100° field of view (Phoenix ICON) · 1240x1240 · wide-field fundus photograph of an infant
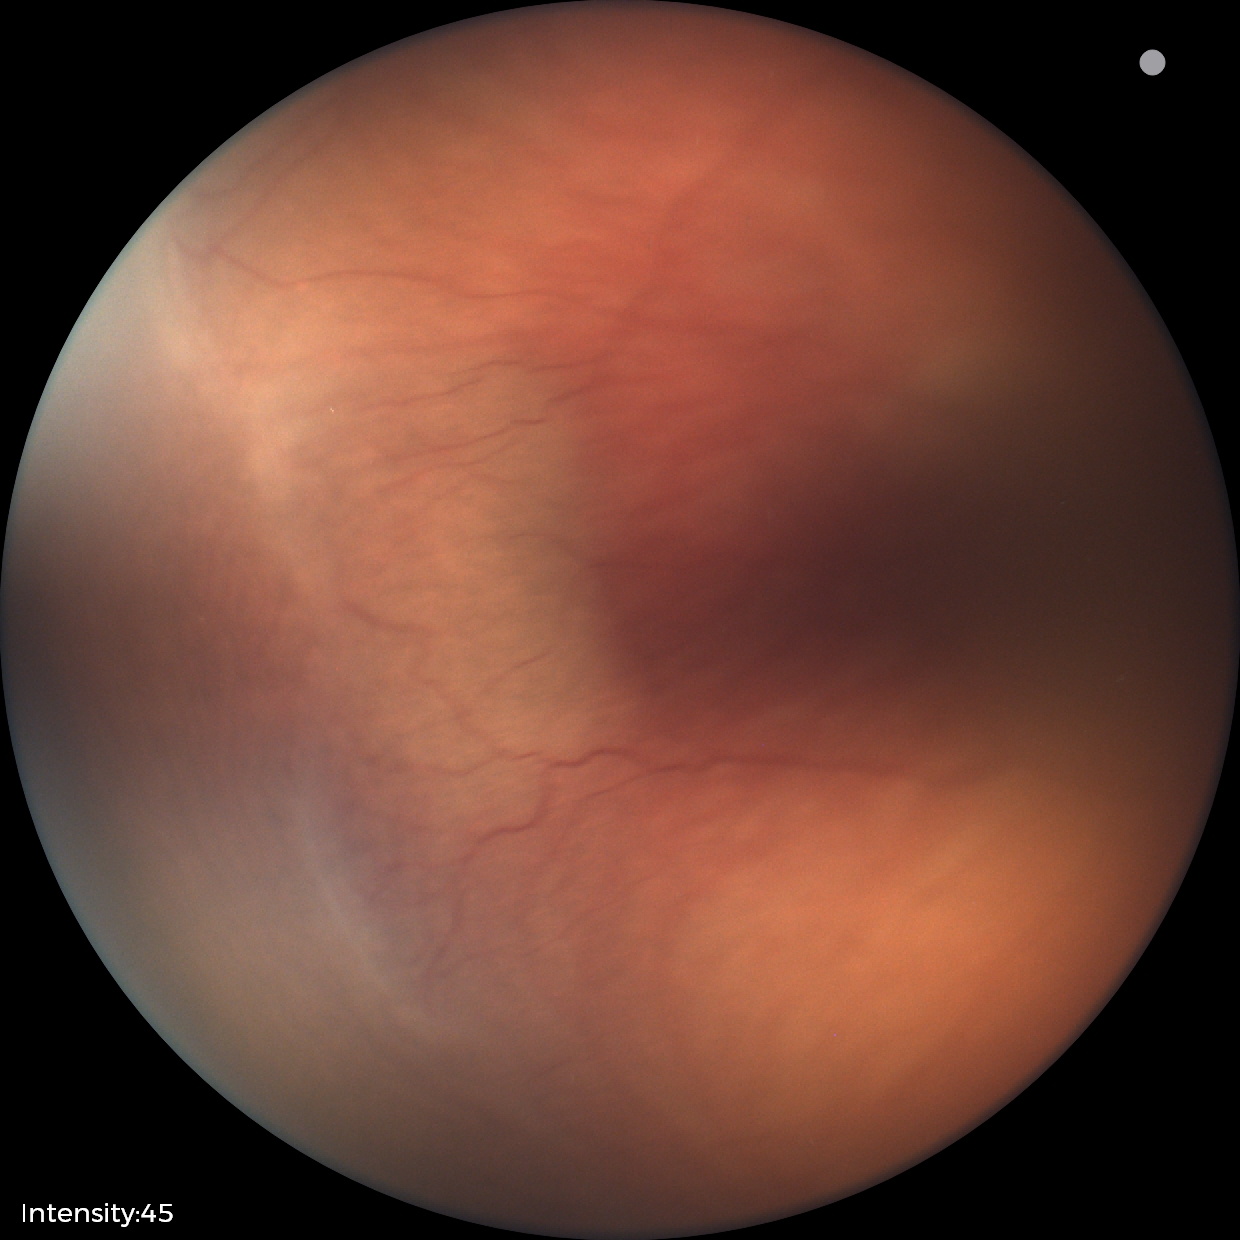 Plus disease absent.
Screening series with ROP stage 2.